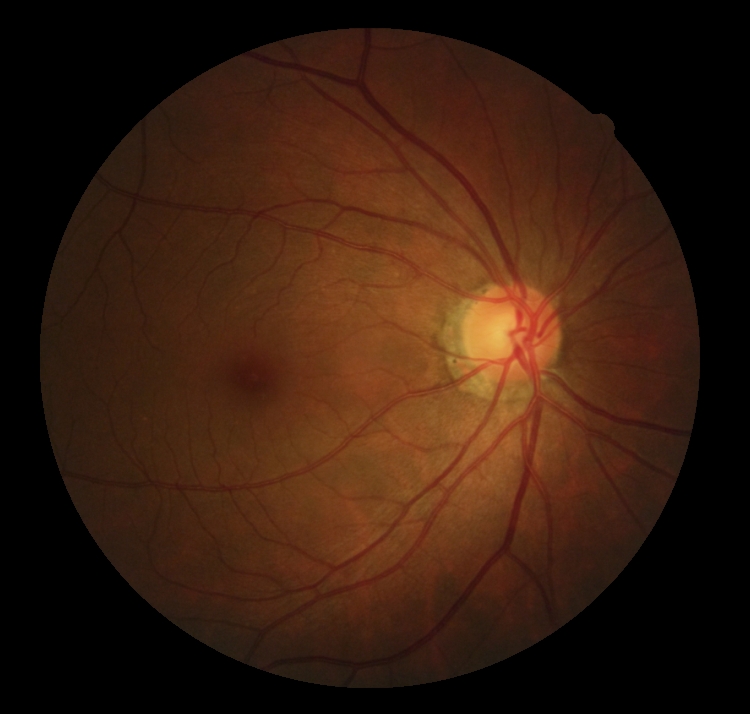 dr_grade: 0/4
dr_impression: negative for DR